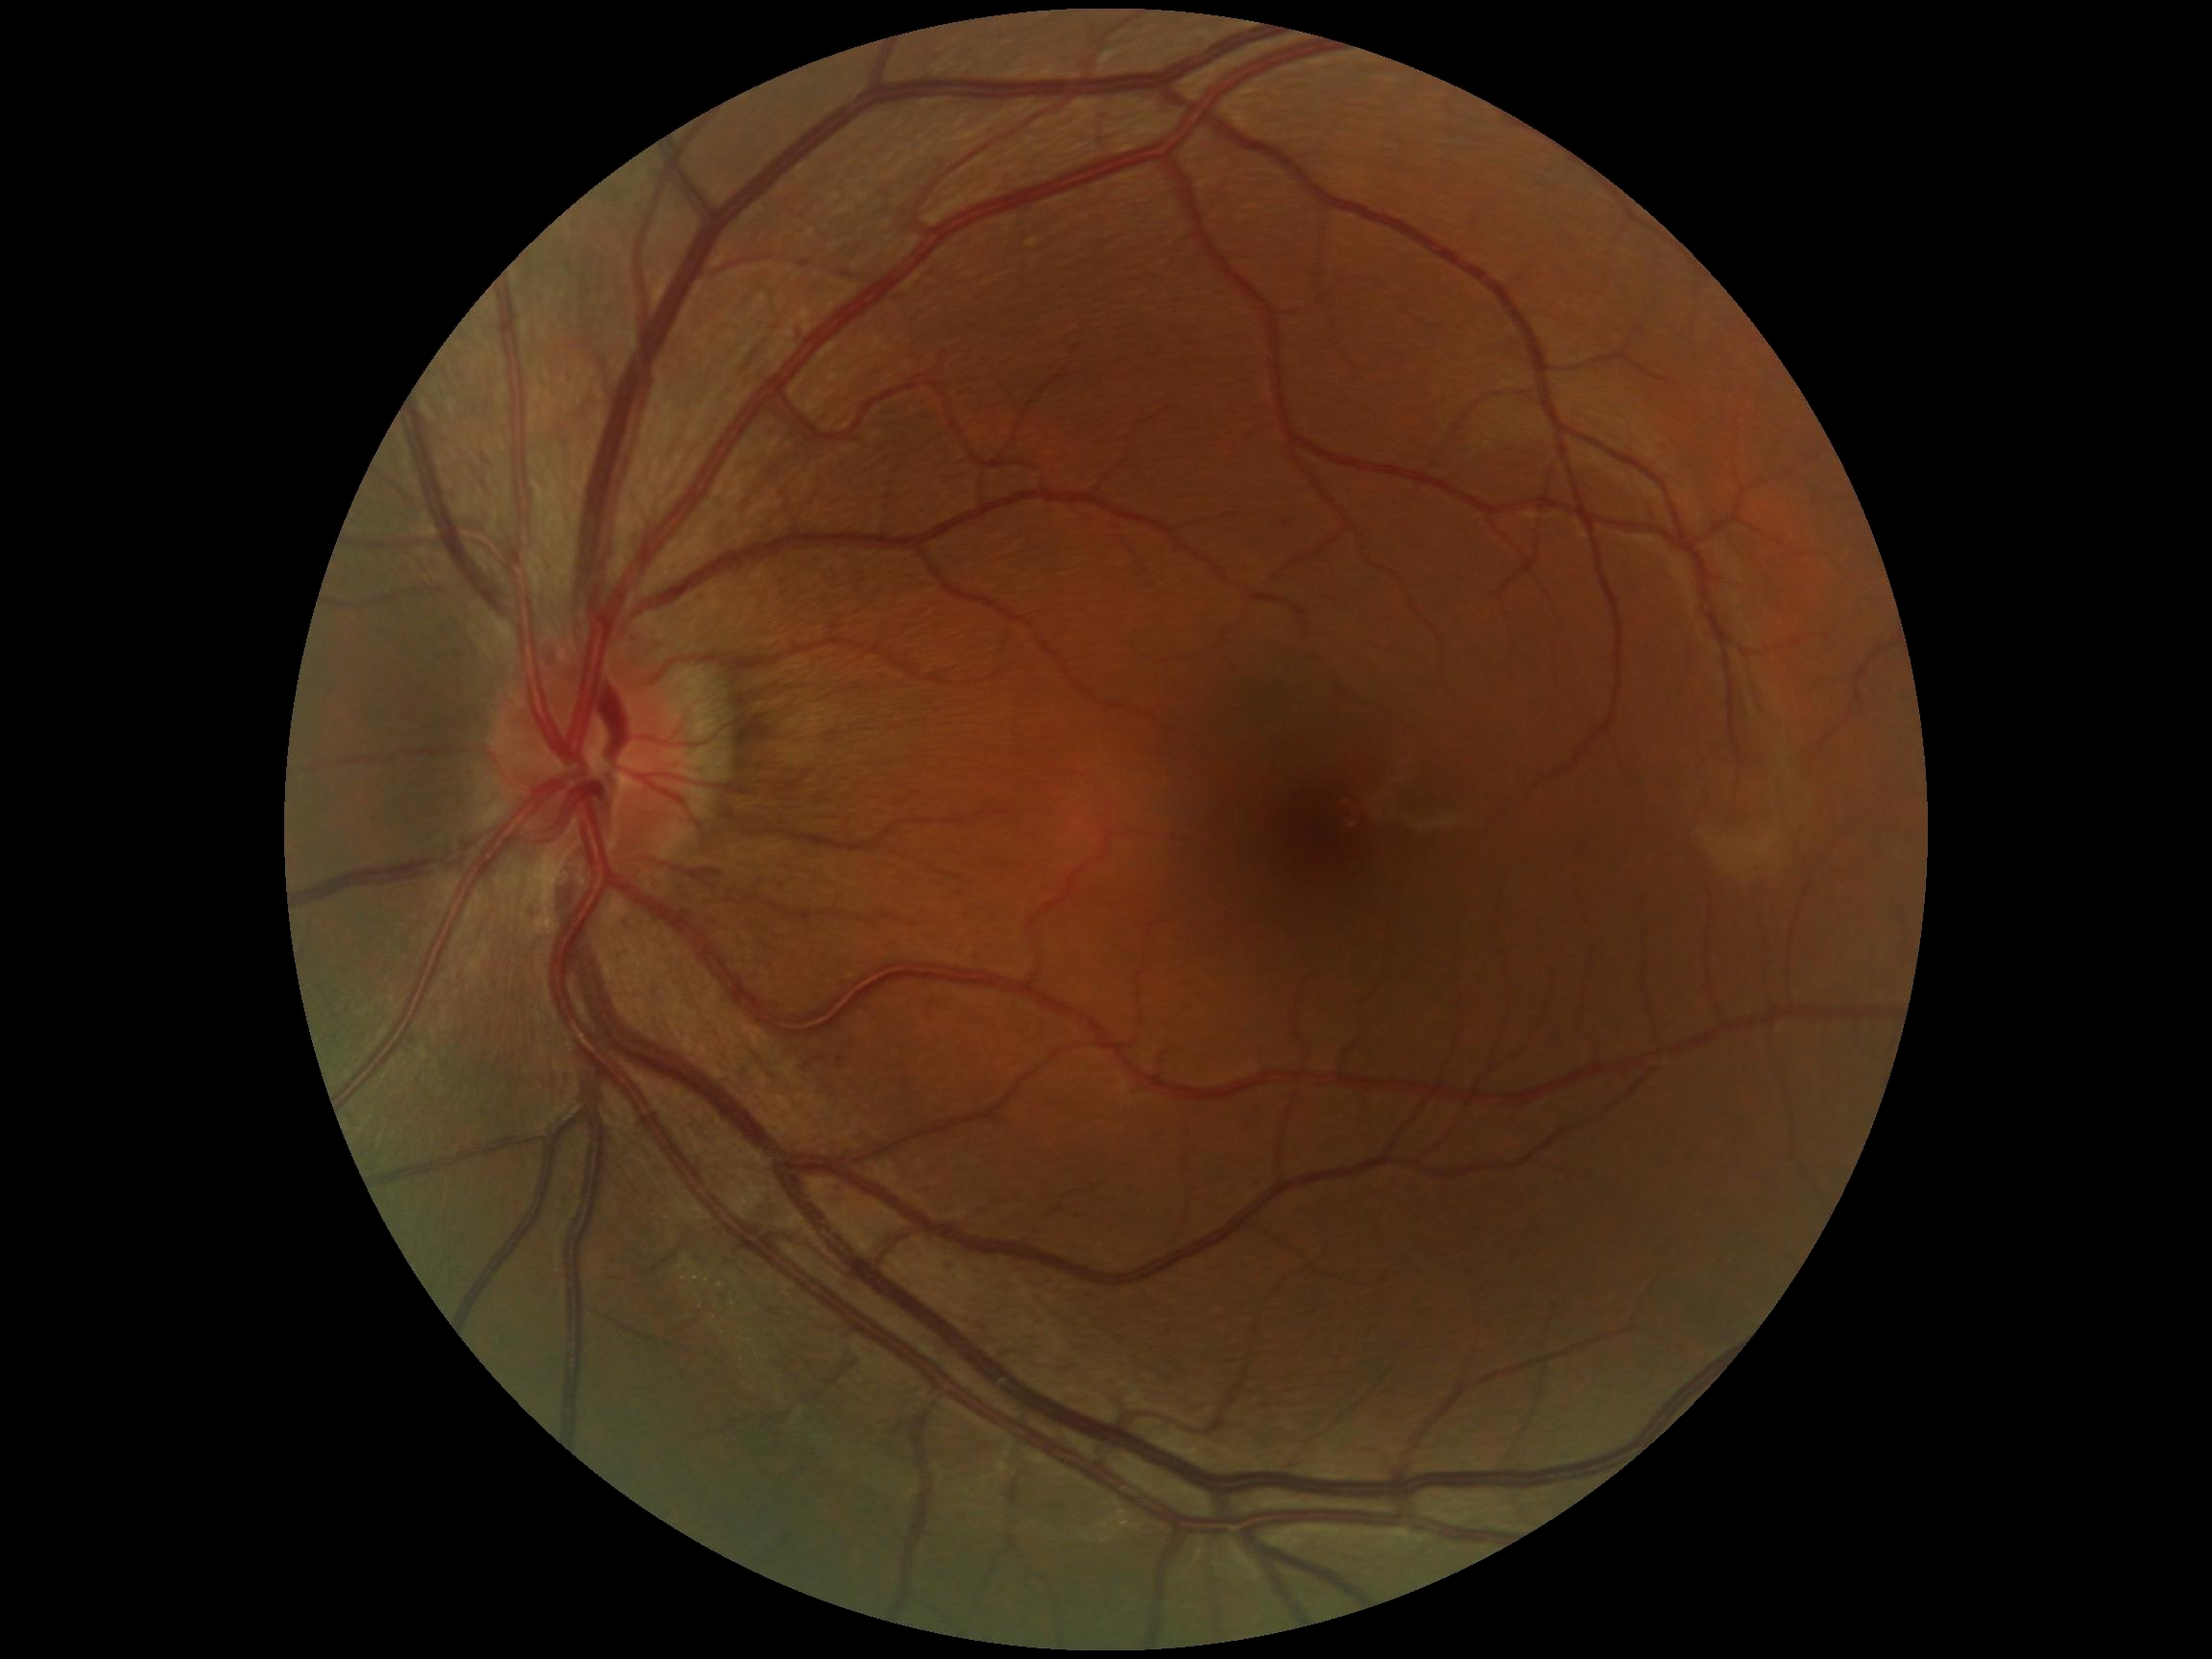

No DR findings. Diabetic retinopathy (DR) is grade 0.